Fundus photo · 45-degree field of view · 2352x1568:
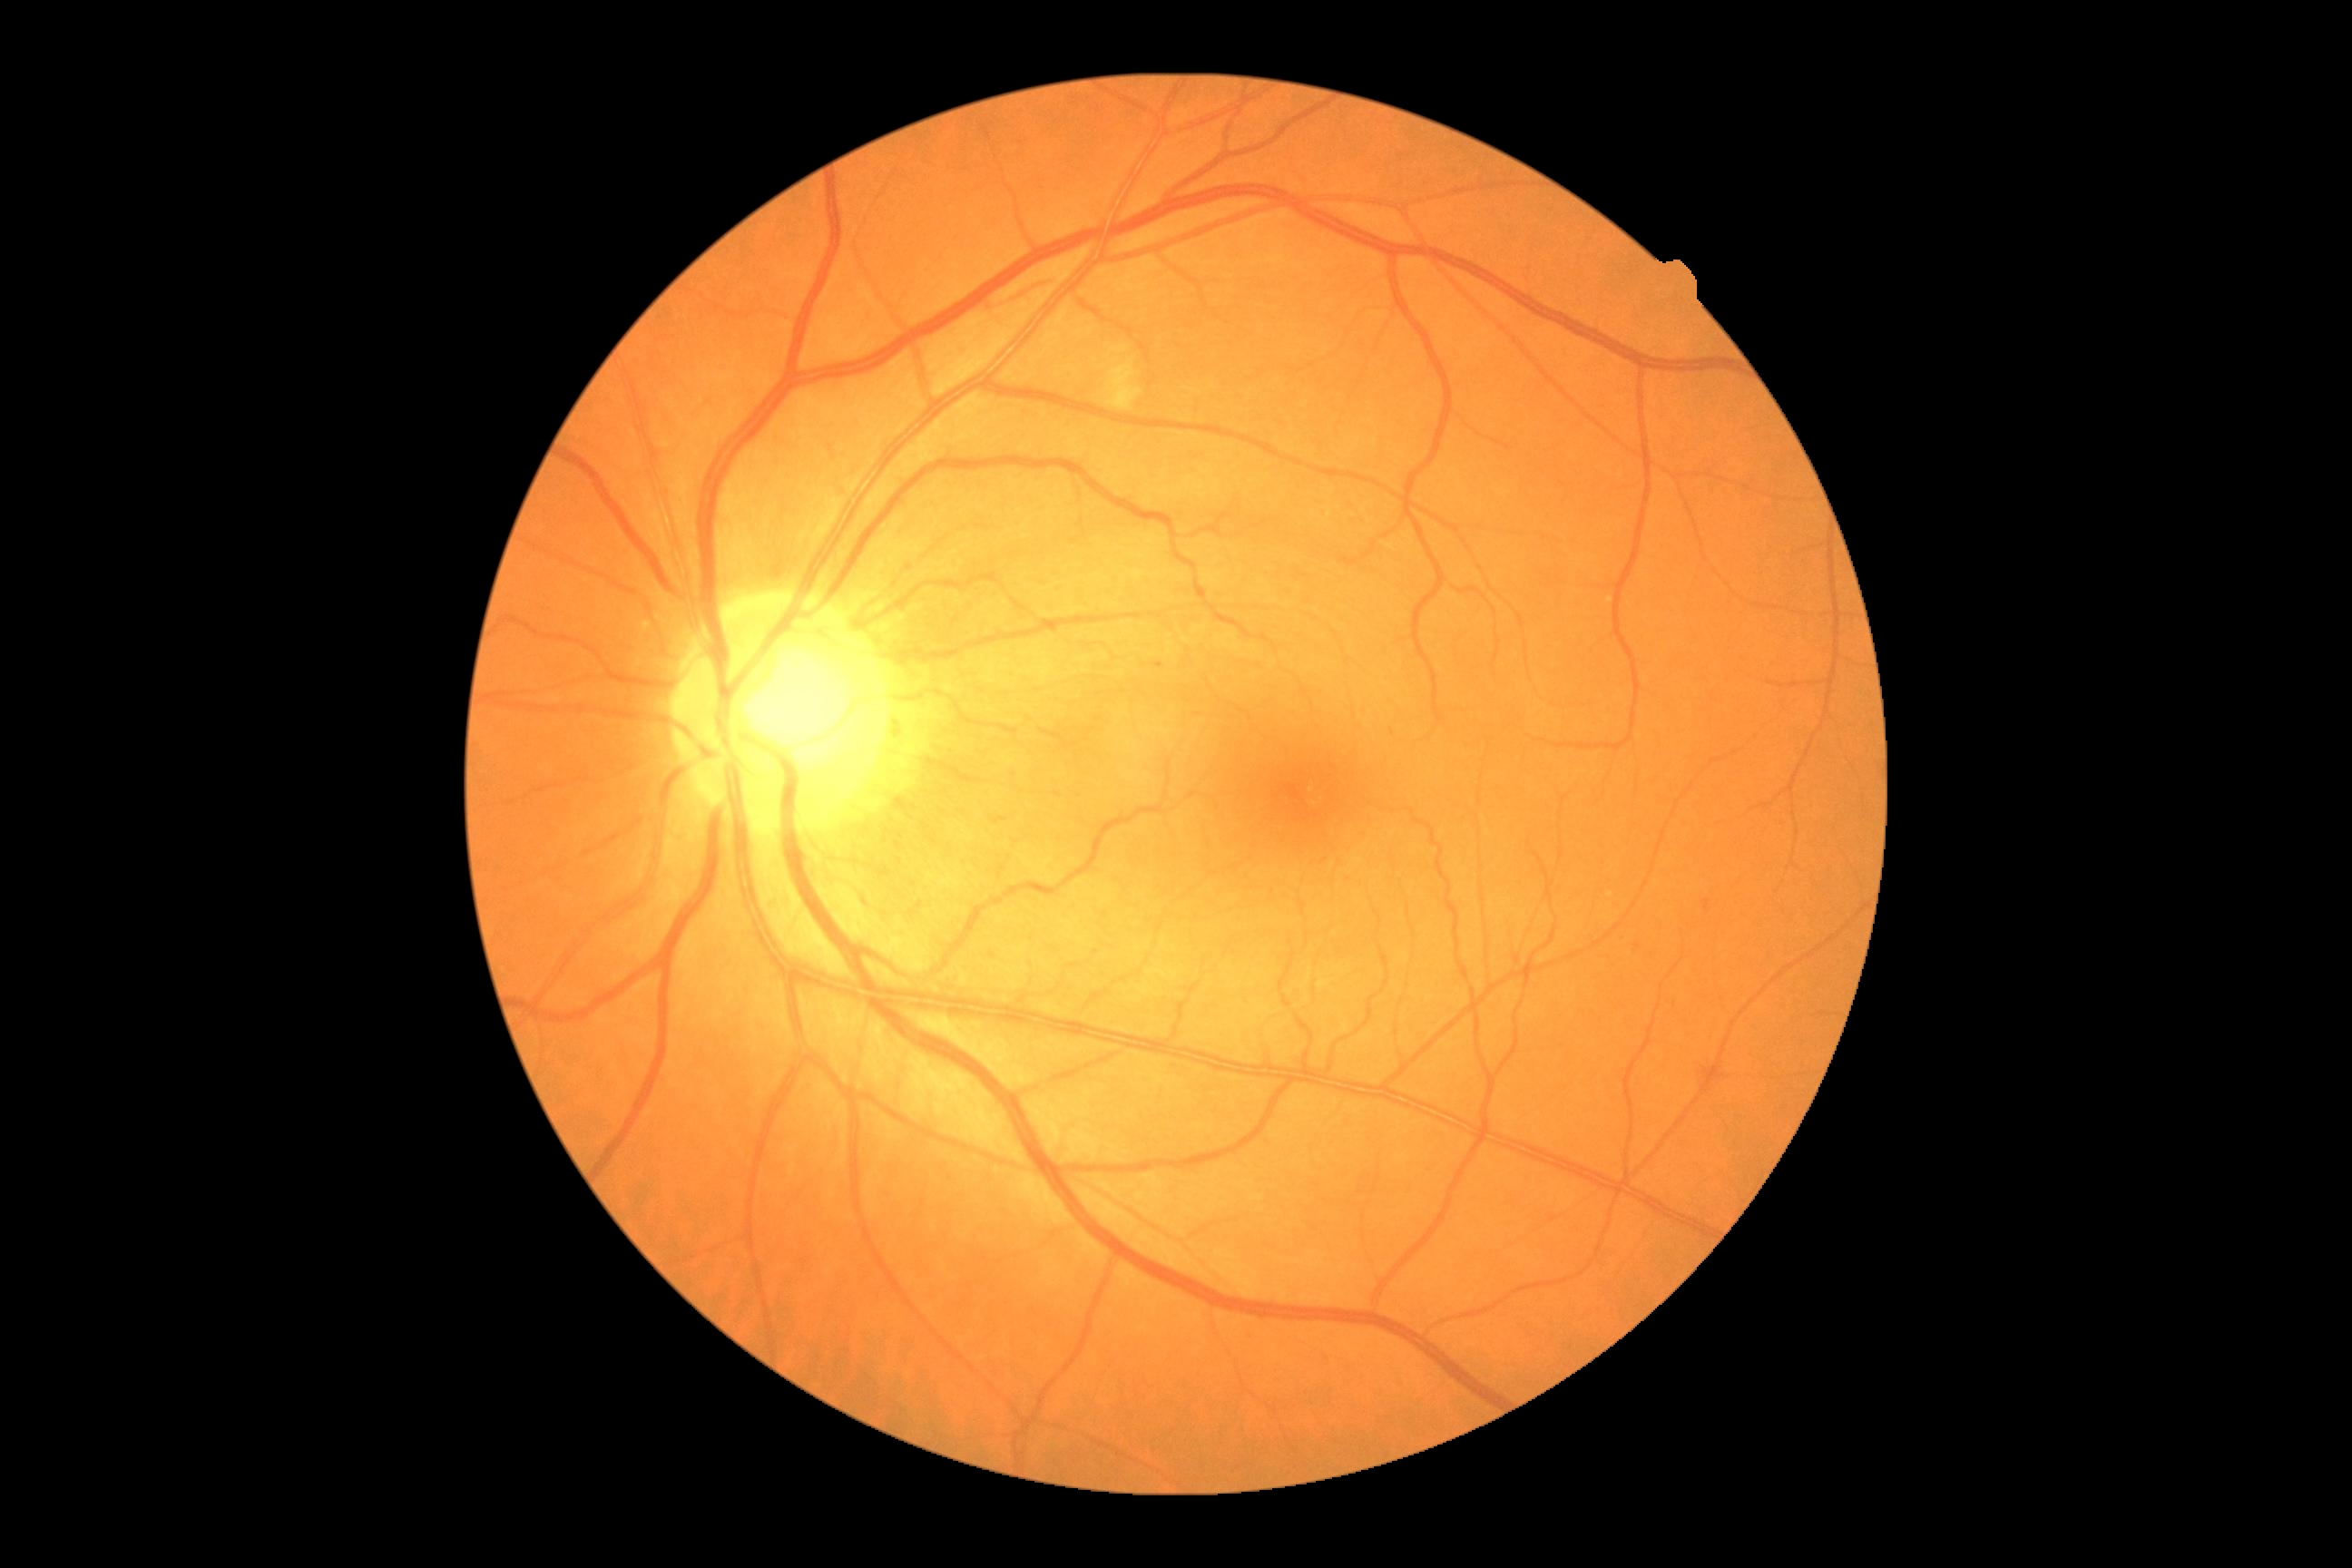 Disease class: non-proliferative diabetic retinopathy.
Diabetic retinopathy severity: grade 2 — more than just microaneurysms but less than severe NPDR.